Retinal fundus photograph, image size 2048x1536:
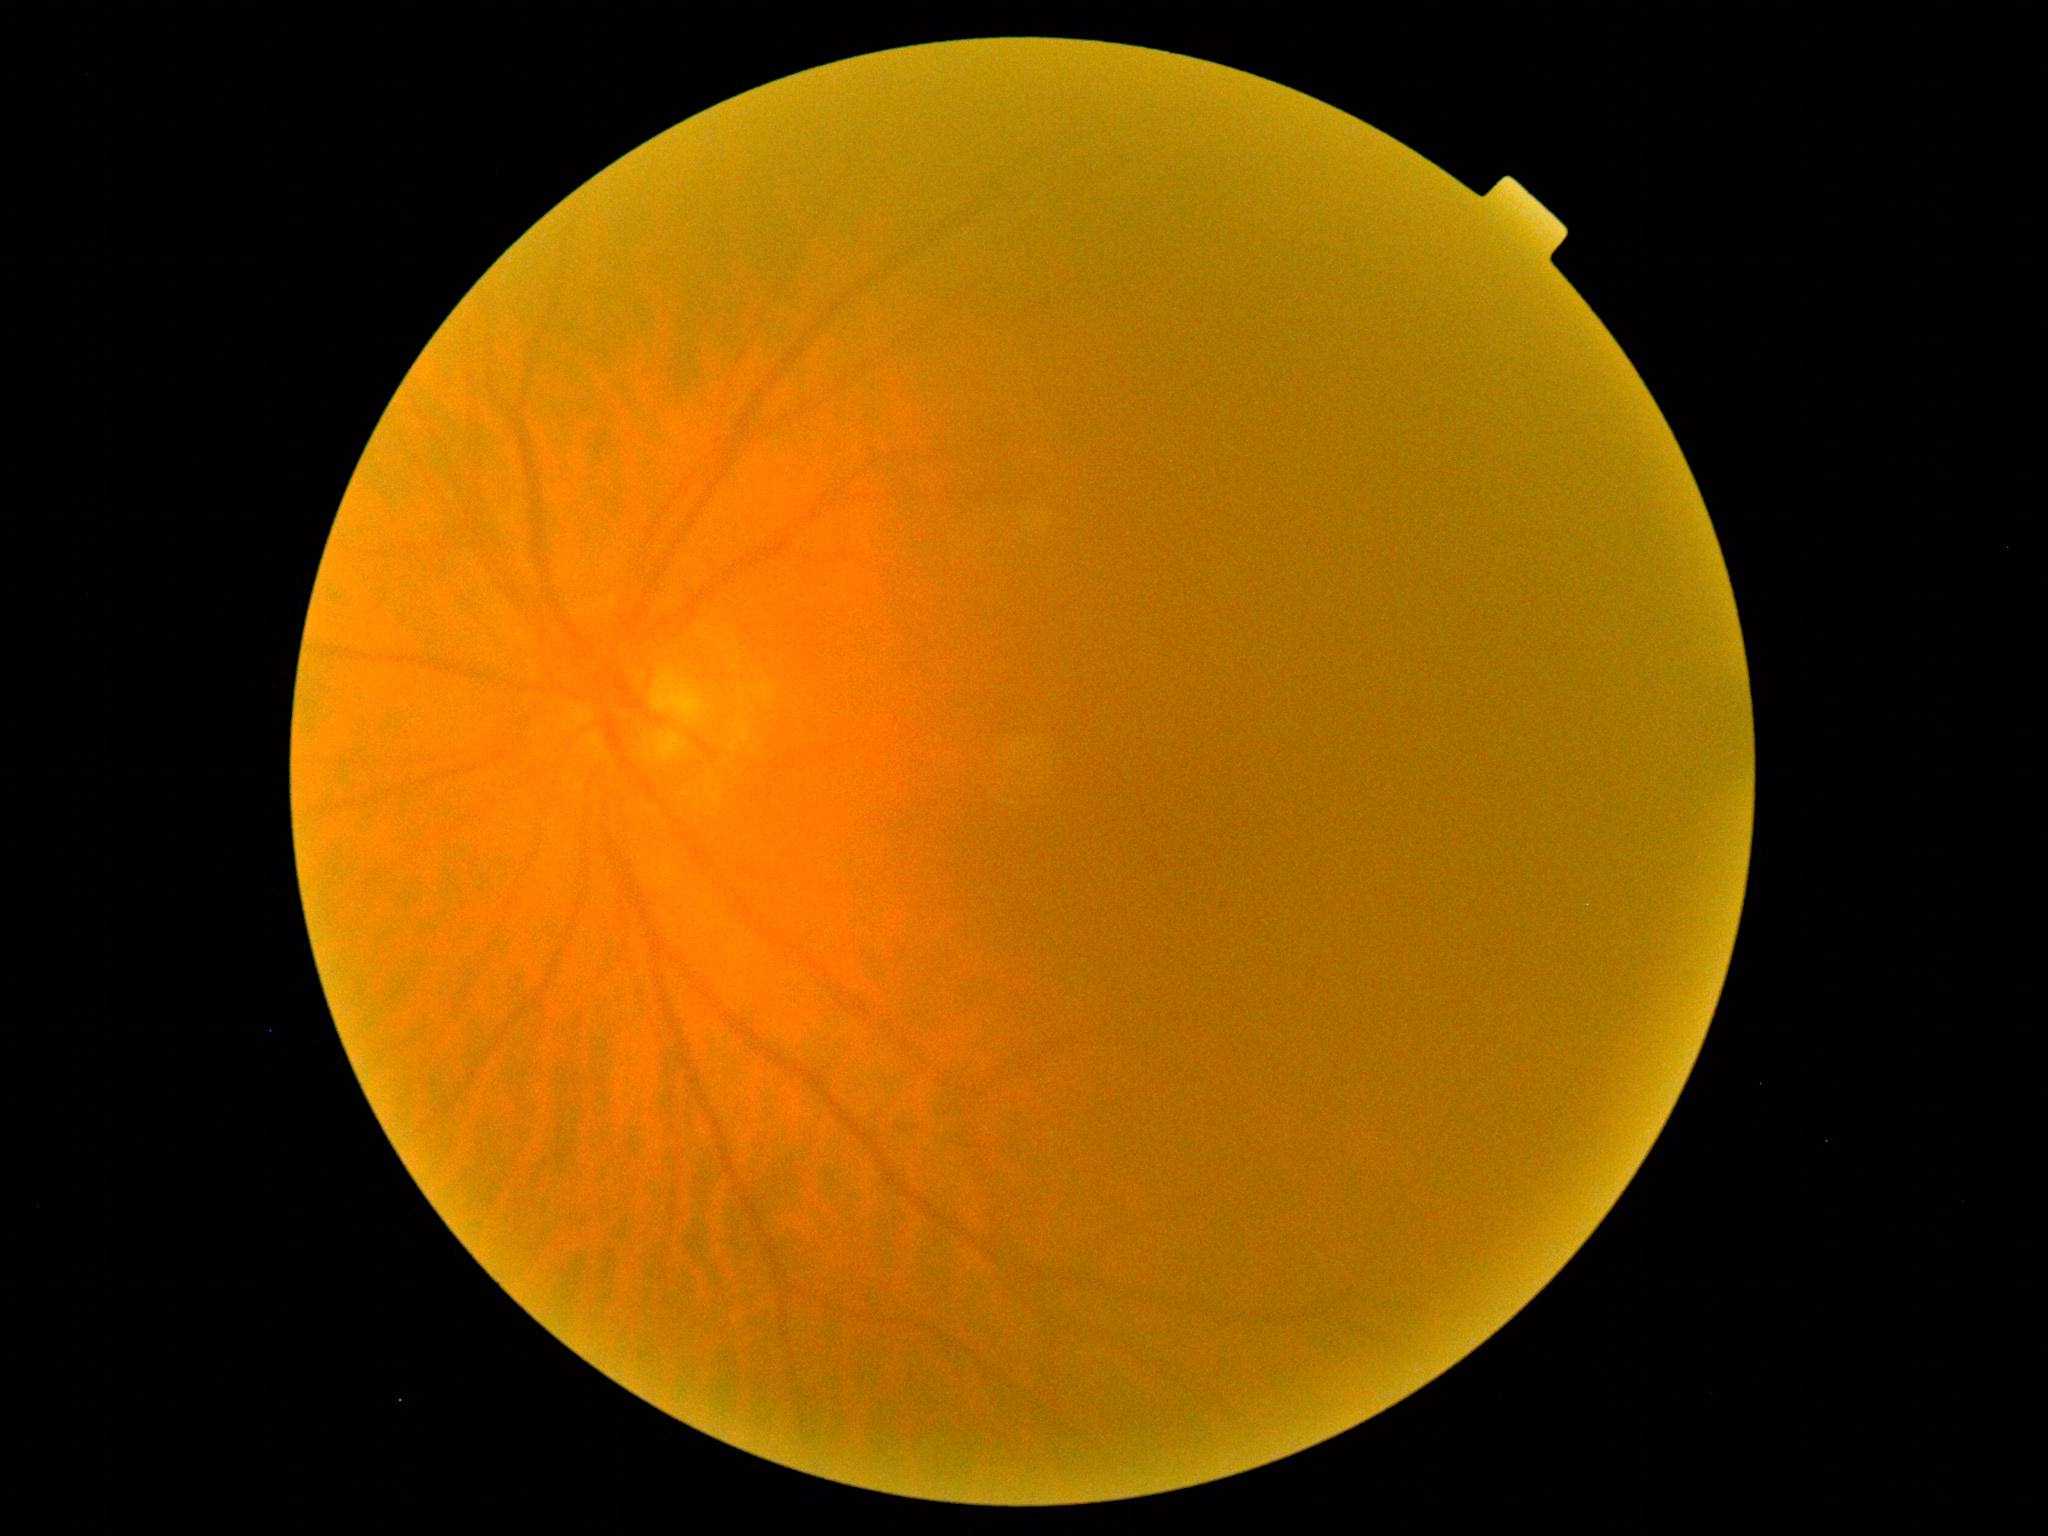

diabetic retinopathy grade = 0 (no apparent retinopathy).